Without pupil dilation: 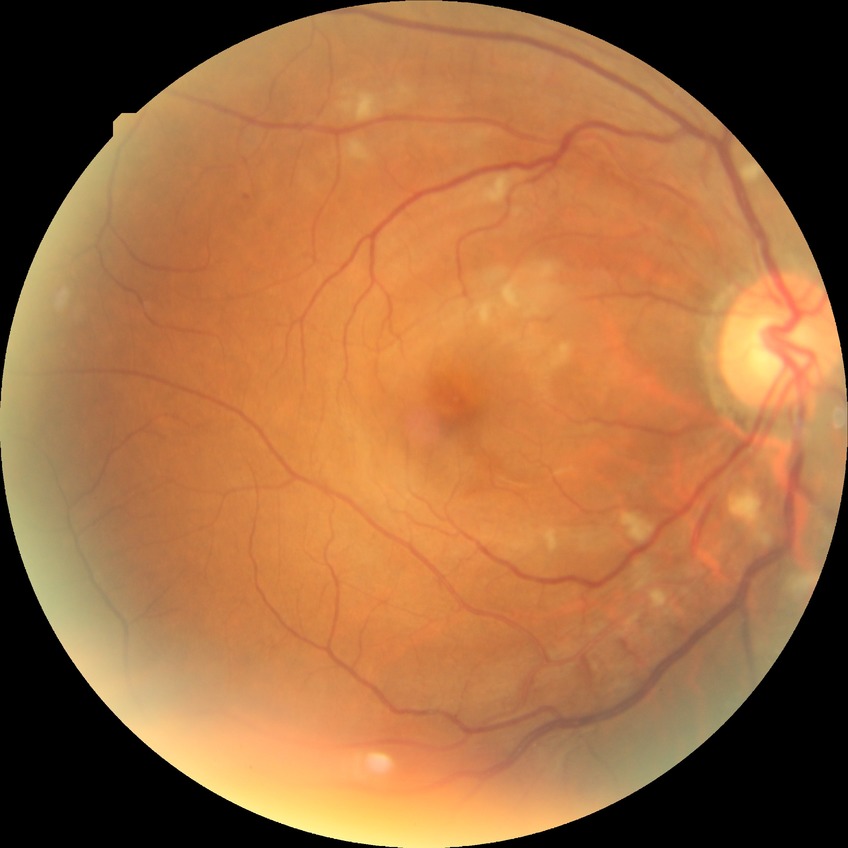

Modified Davis classification: pre-proliferative diabetic retinopathy.